DR severity per modified Davis staging
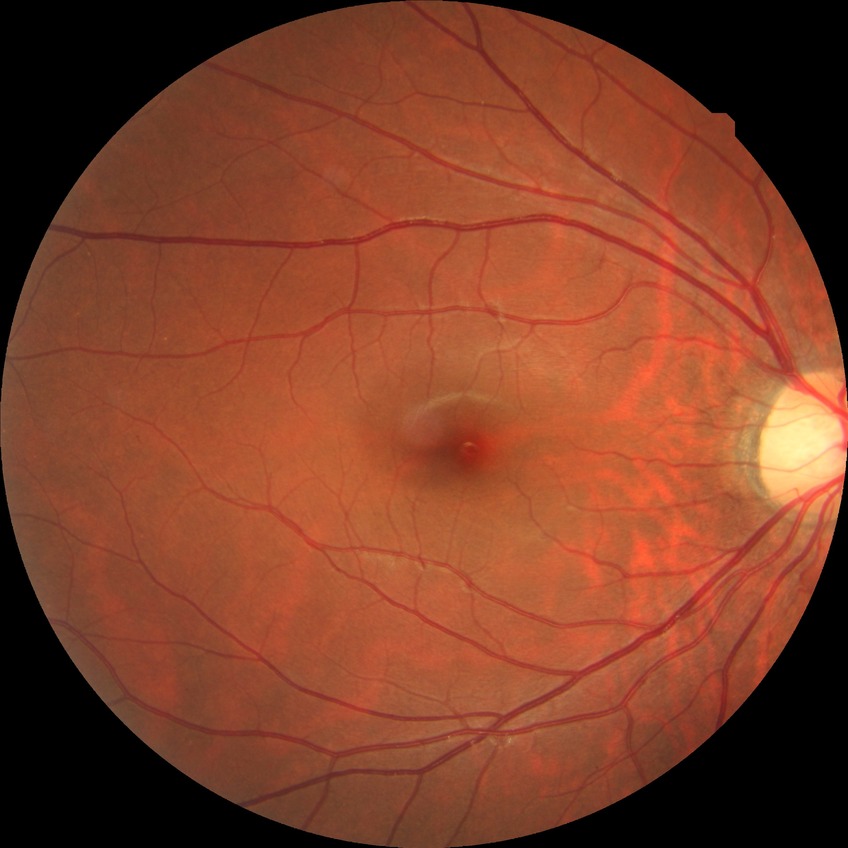

diabetic retinopathy (DR) = no diabetic retinopathy (NDR).